100° field of view (Phoenix ICON); wide-field fundus photograph of an infant
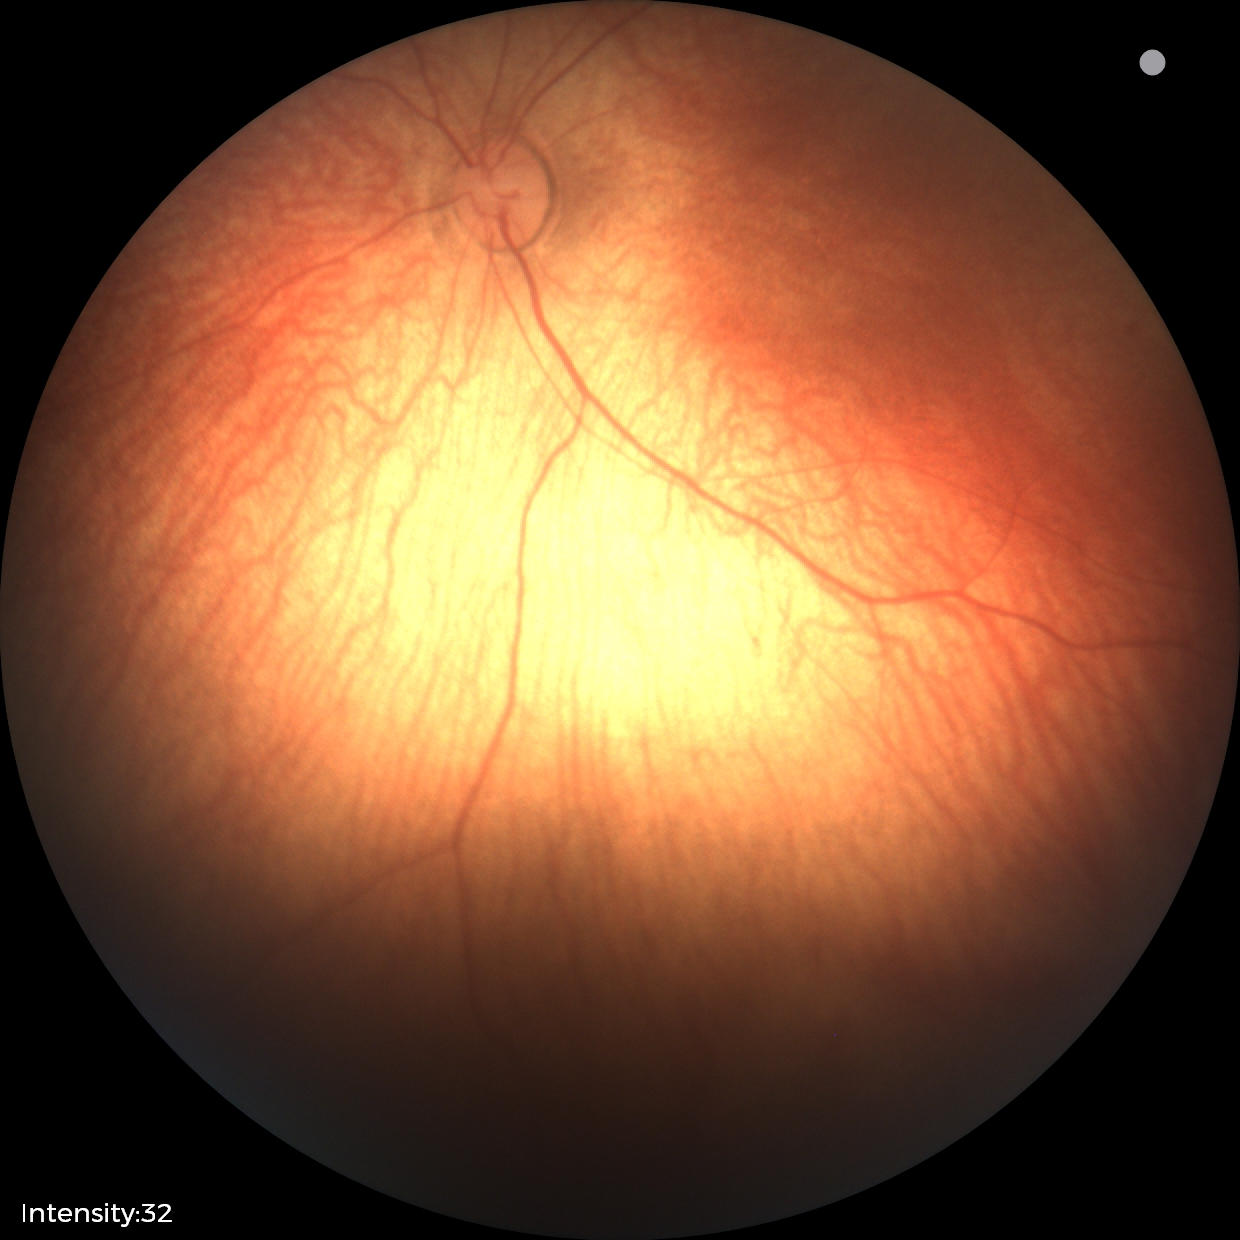
Screening examination diagnosed as physiological.